848x848px, 45° FOV, posterior pole photograph, modified Davis classification, without pupil dilation, acquired with a NIDEK AFC-230: 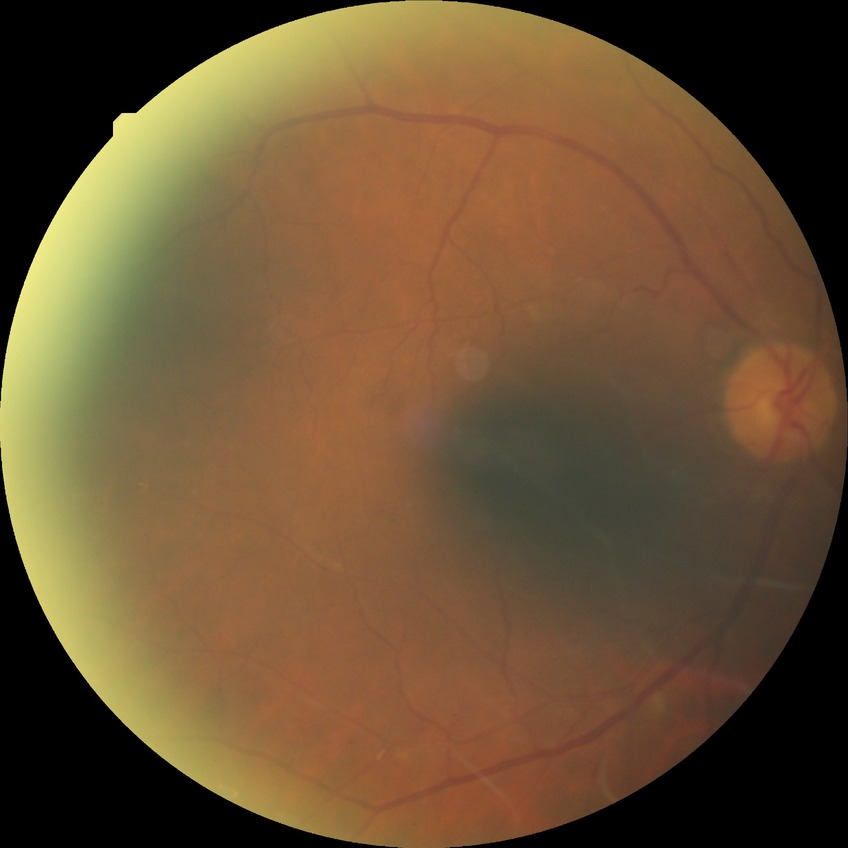

{"davis_grade": "simple diabetic retinopathy (SDR)"}